Nonmydriatic: 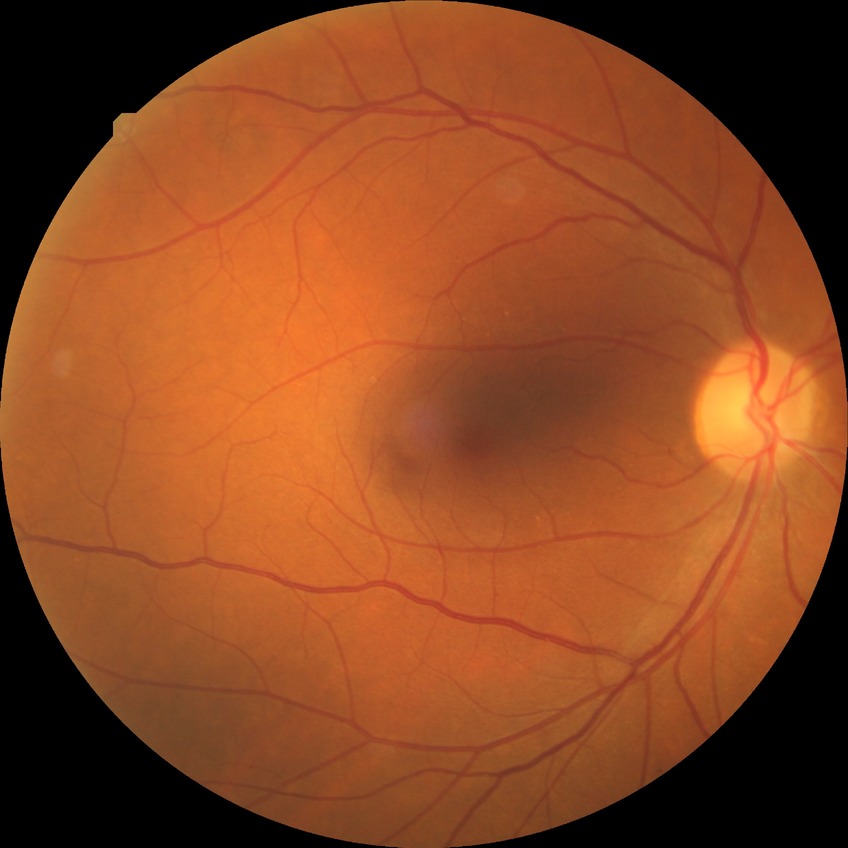

Modified Davis grading: no diabetic retinopathy.